Color fundus photograph: 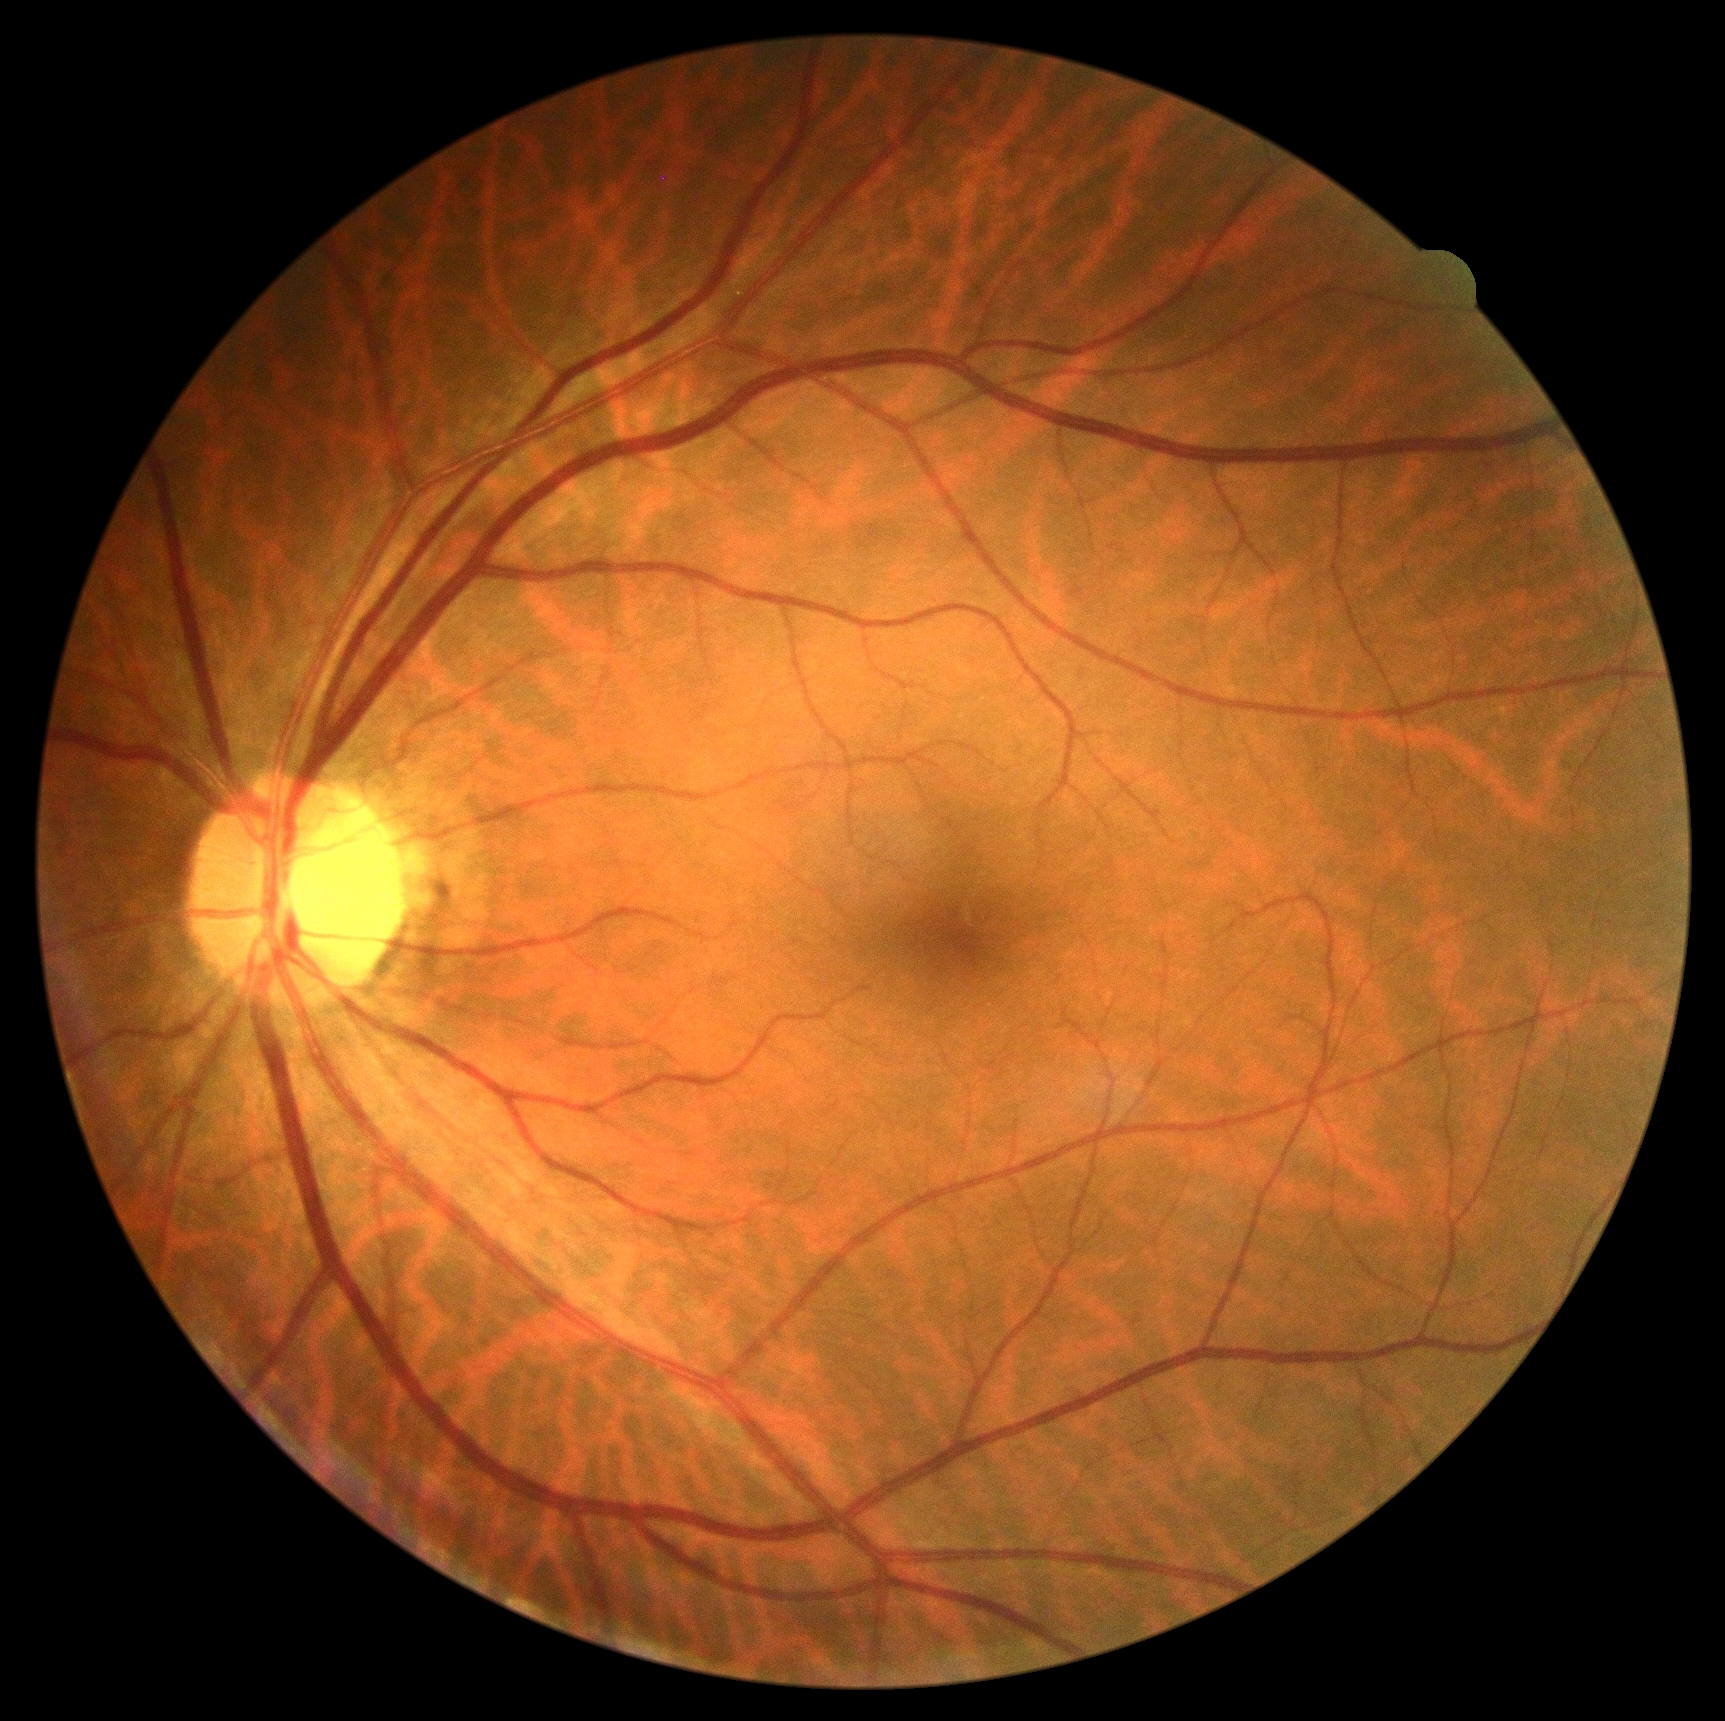
{"dr_grade": "grade 0 (no apparent retinopathy)"}